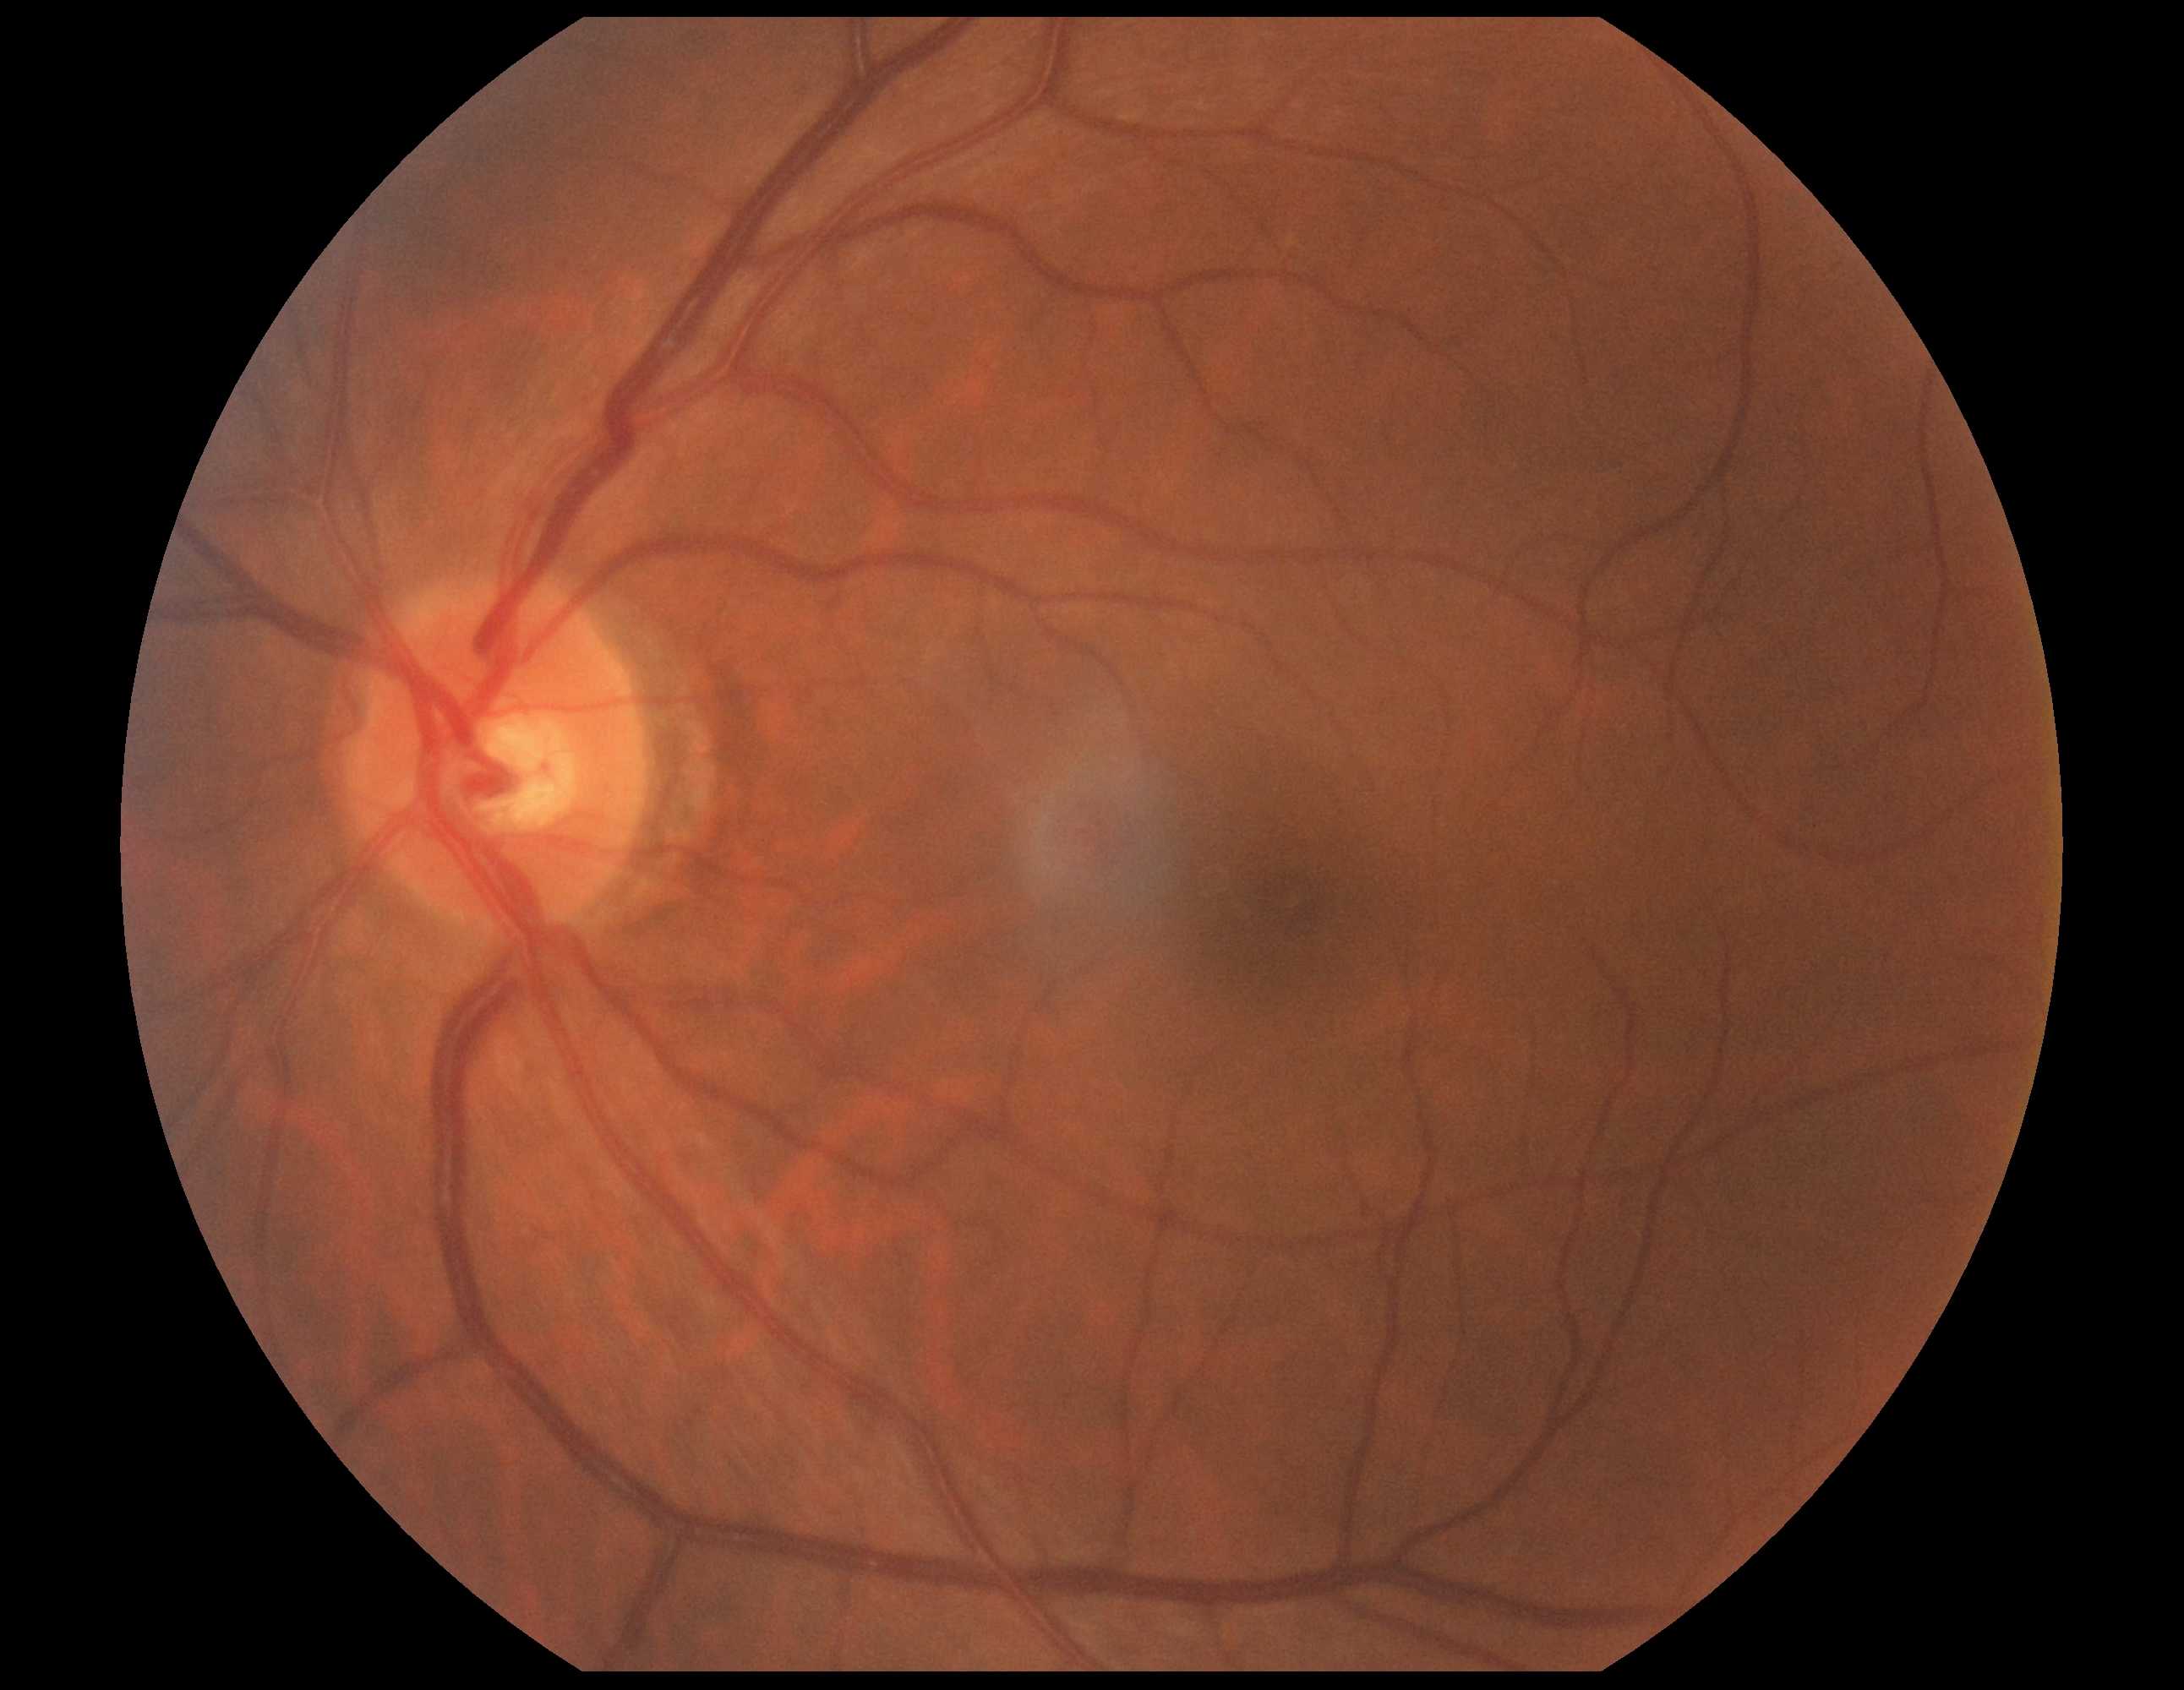

retinopathy grade: no apparent diabetic retinopathy (0).